45-degree field of view.
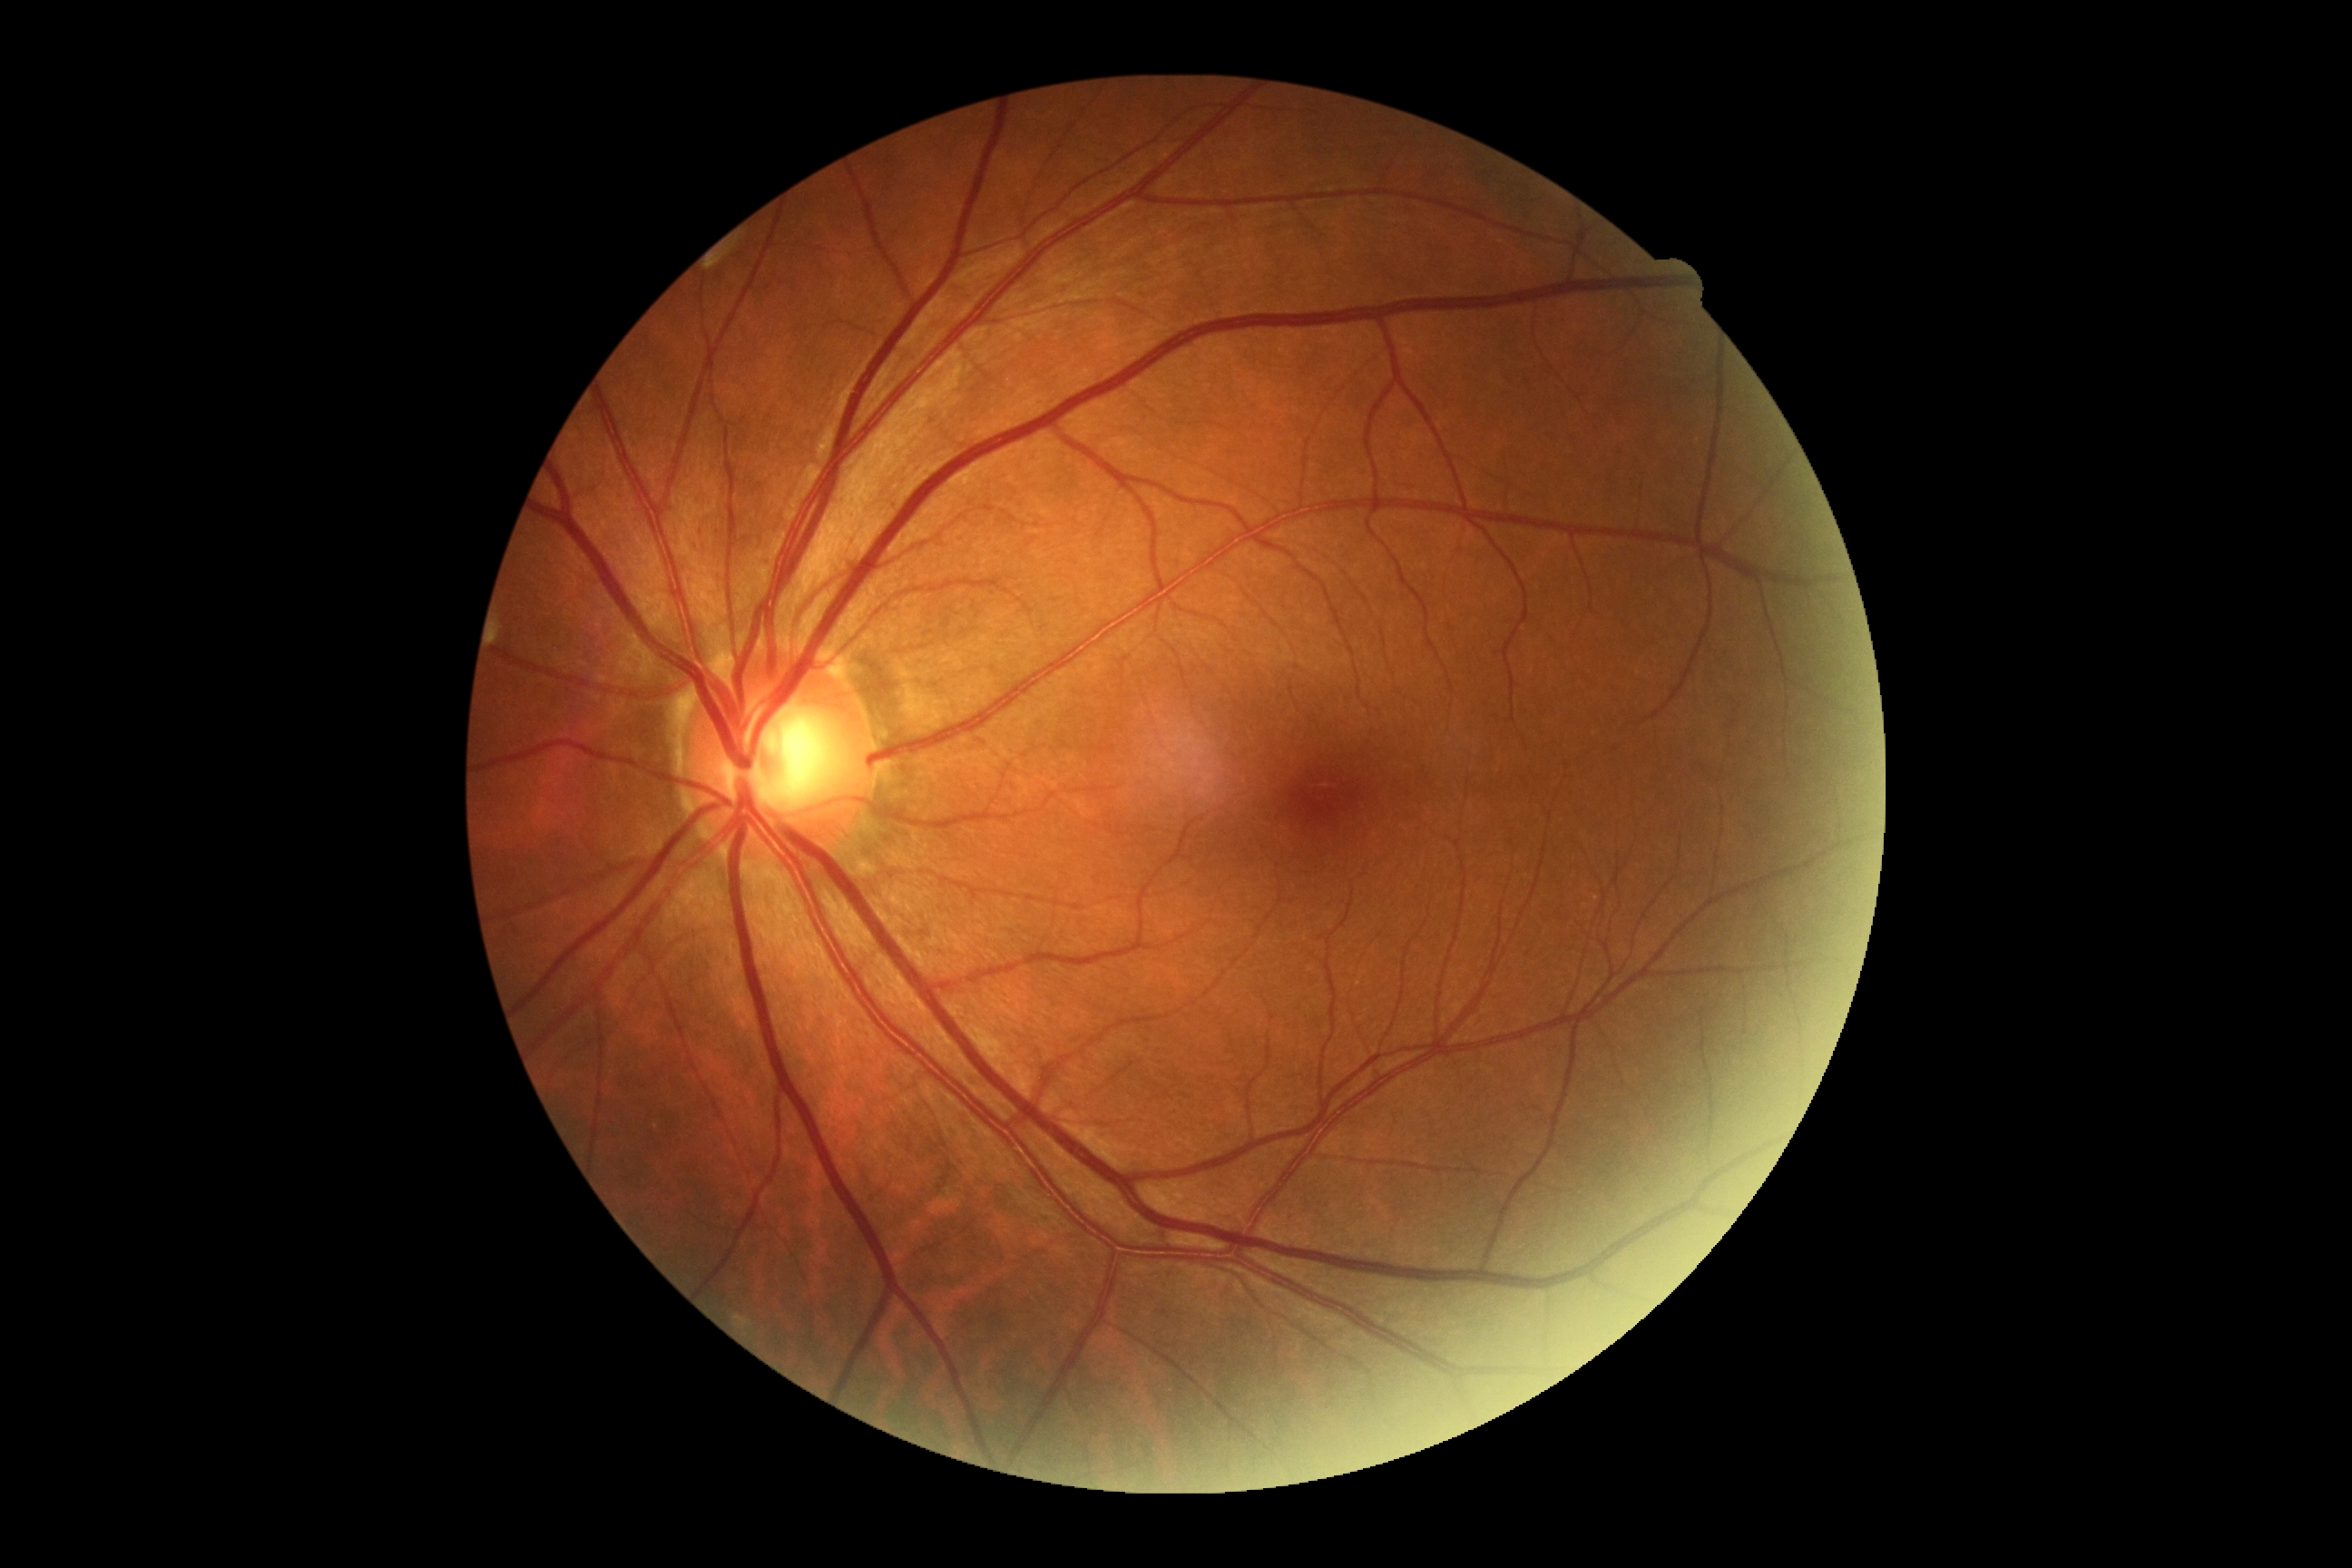
Diabetic retinopathy (DR): grade 0 (no apparent retinopathy). No diabetic retinal disease findings.